Central posterior field
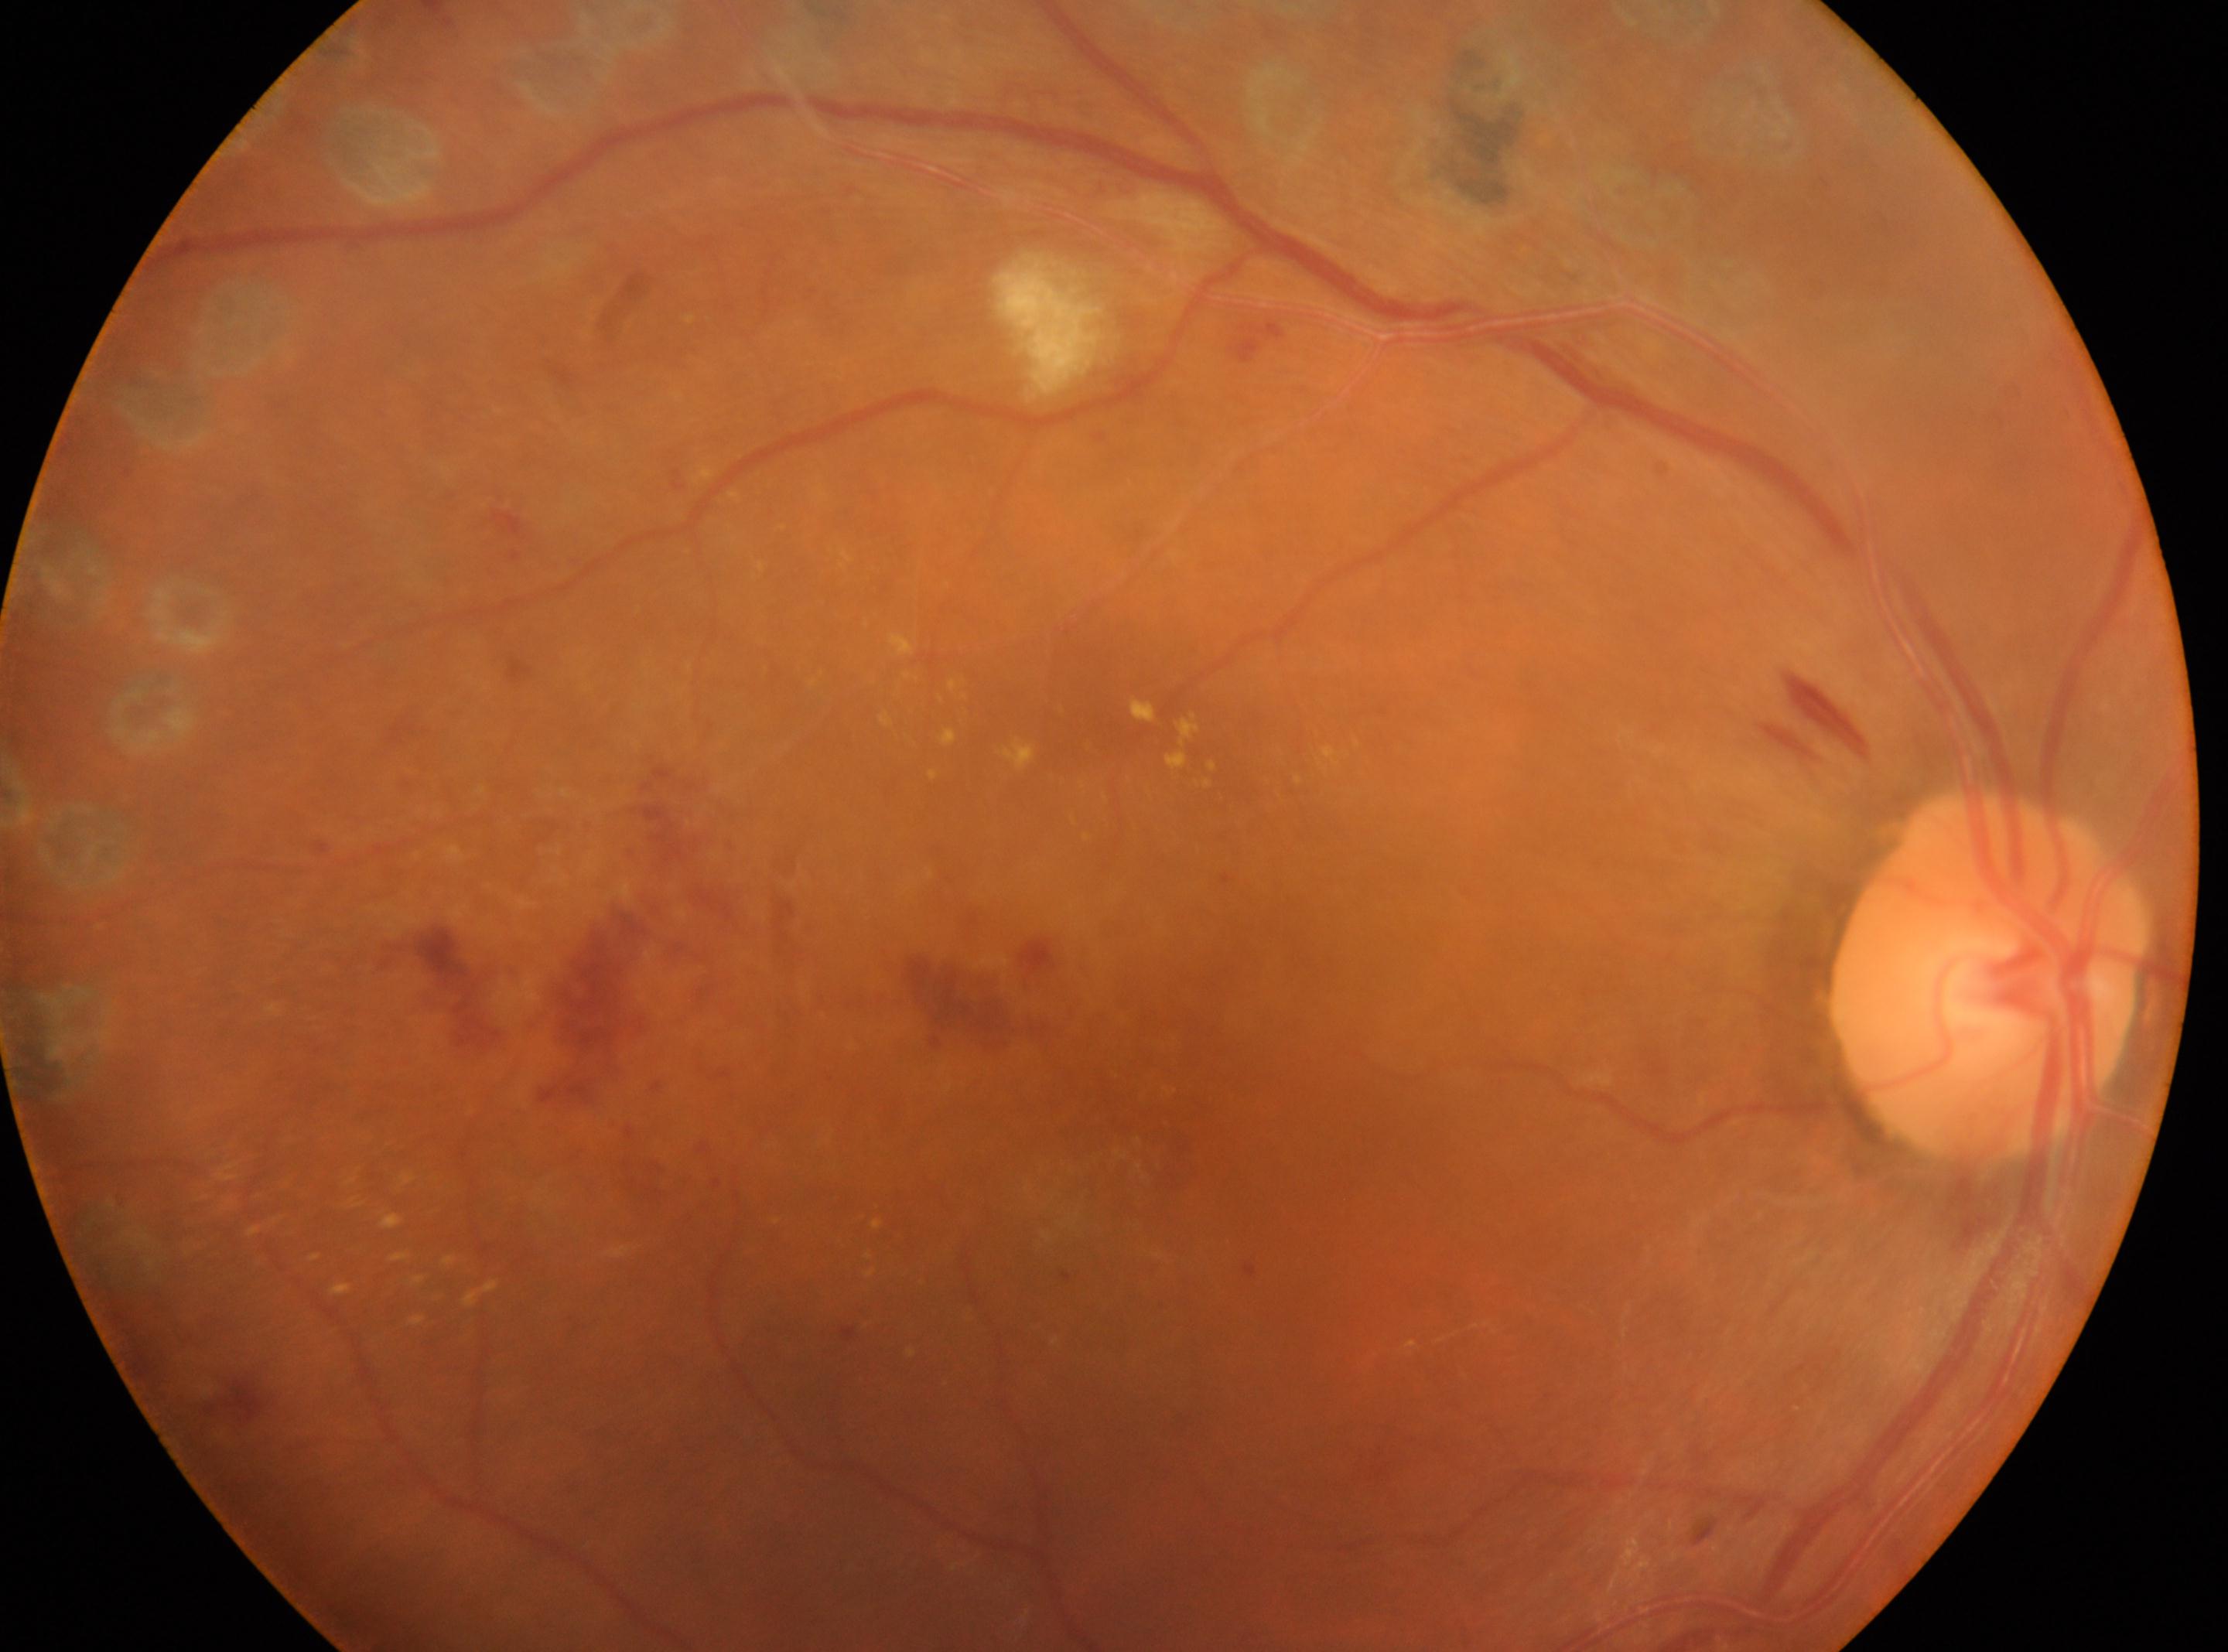
laterality: oculus dexter | the fovea: (x: 1143, y: 1115) | optic disc center: (x: 1987, y: 977) | DR: post-photocoagulation DR, with underlying moderate non-proliferative diabetic retinopathy (grade 2).